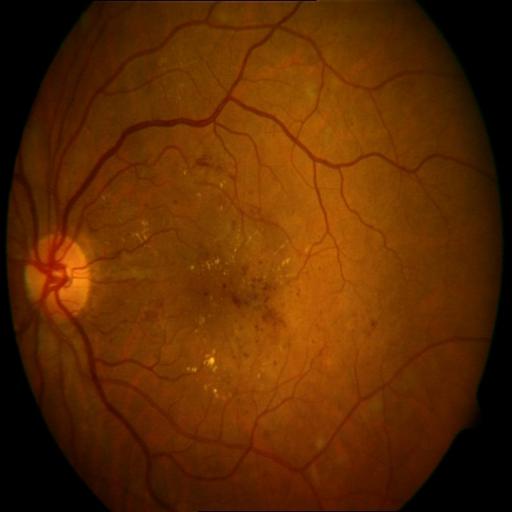
Diagnosis:
- hemorrhagic retinopathy